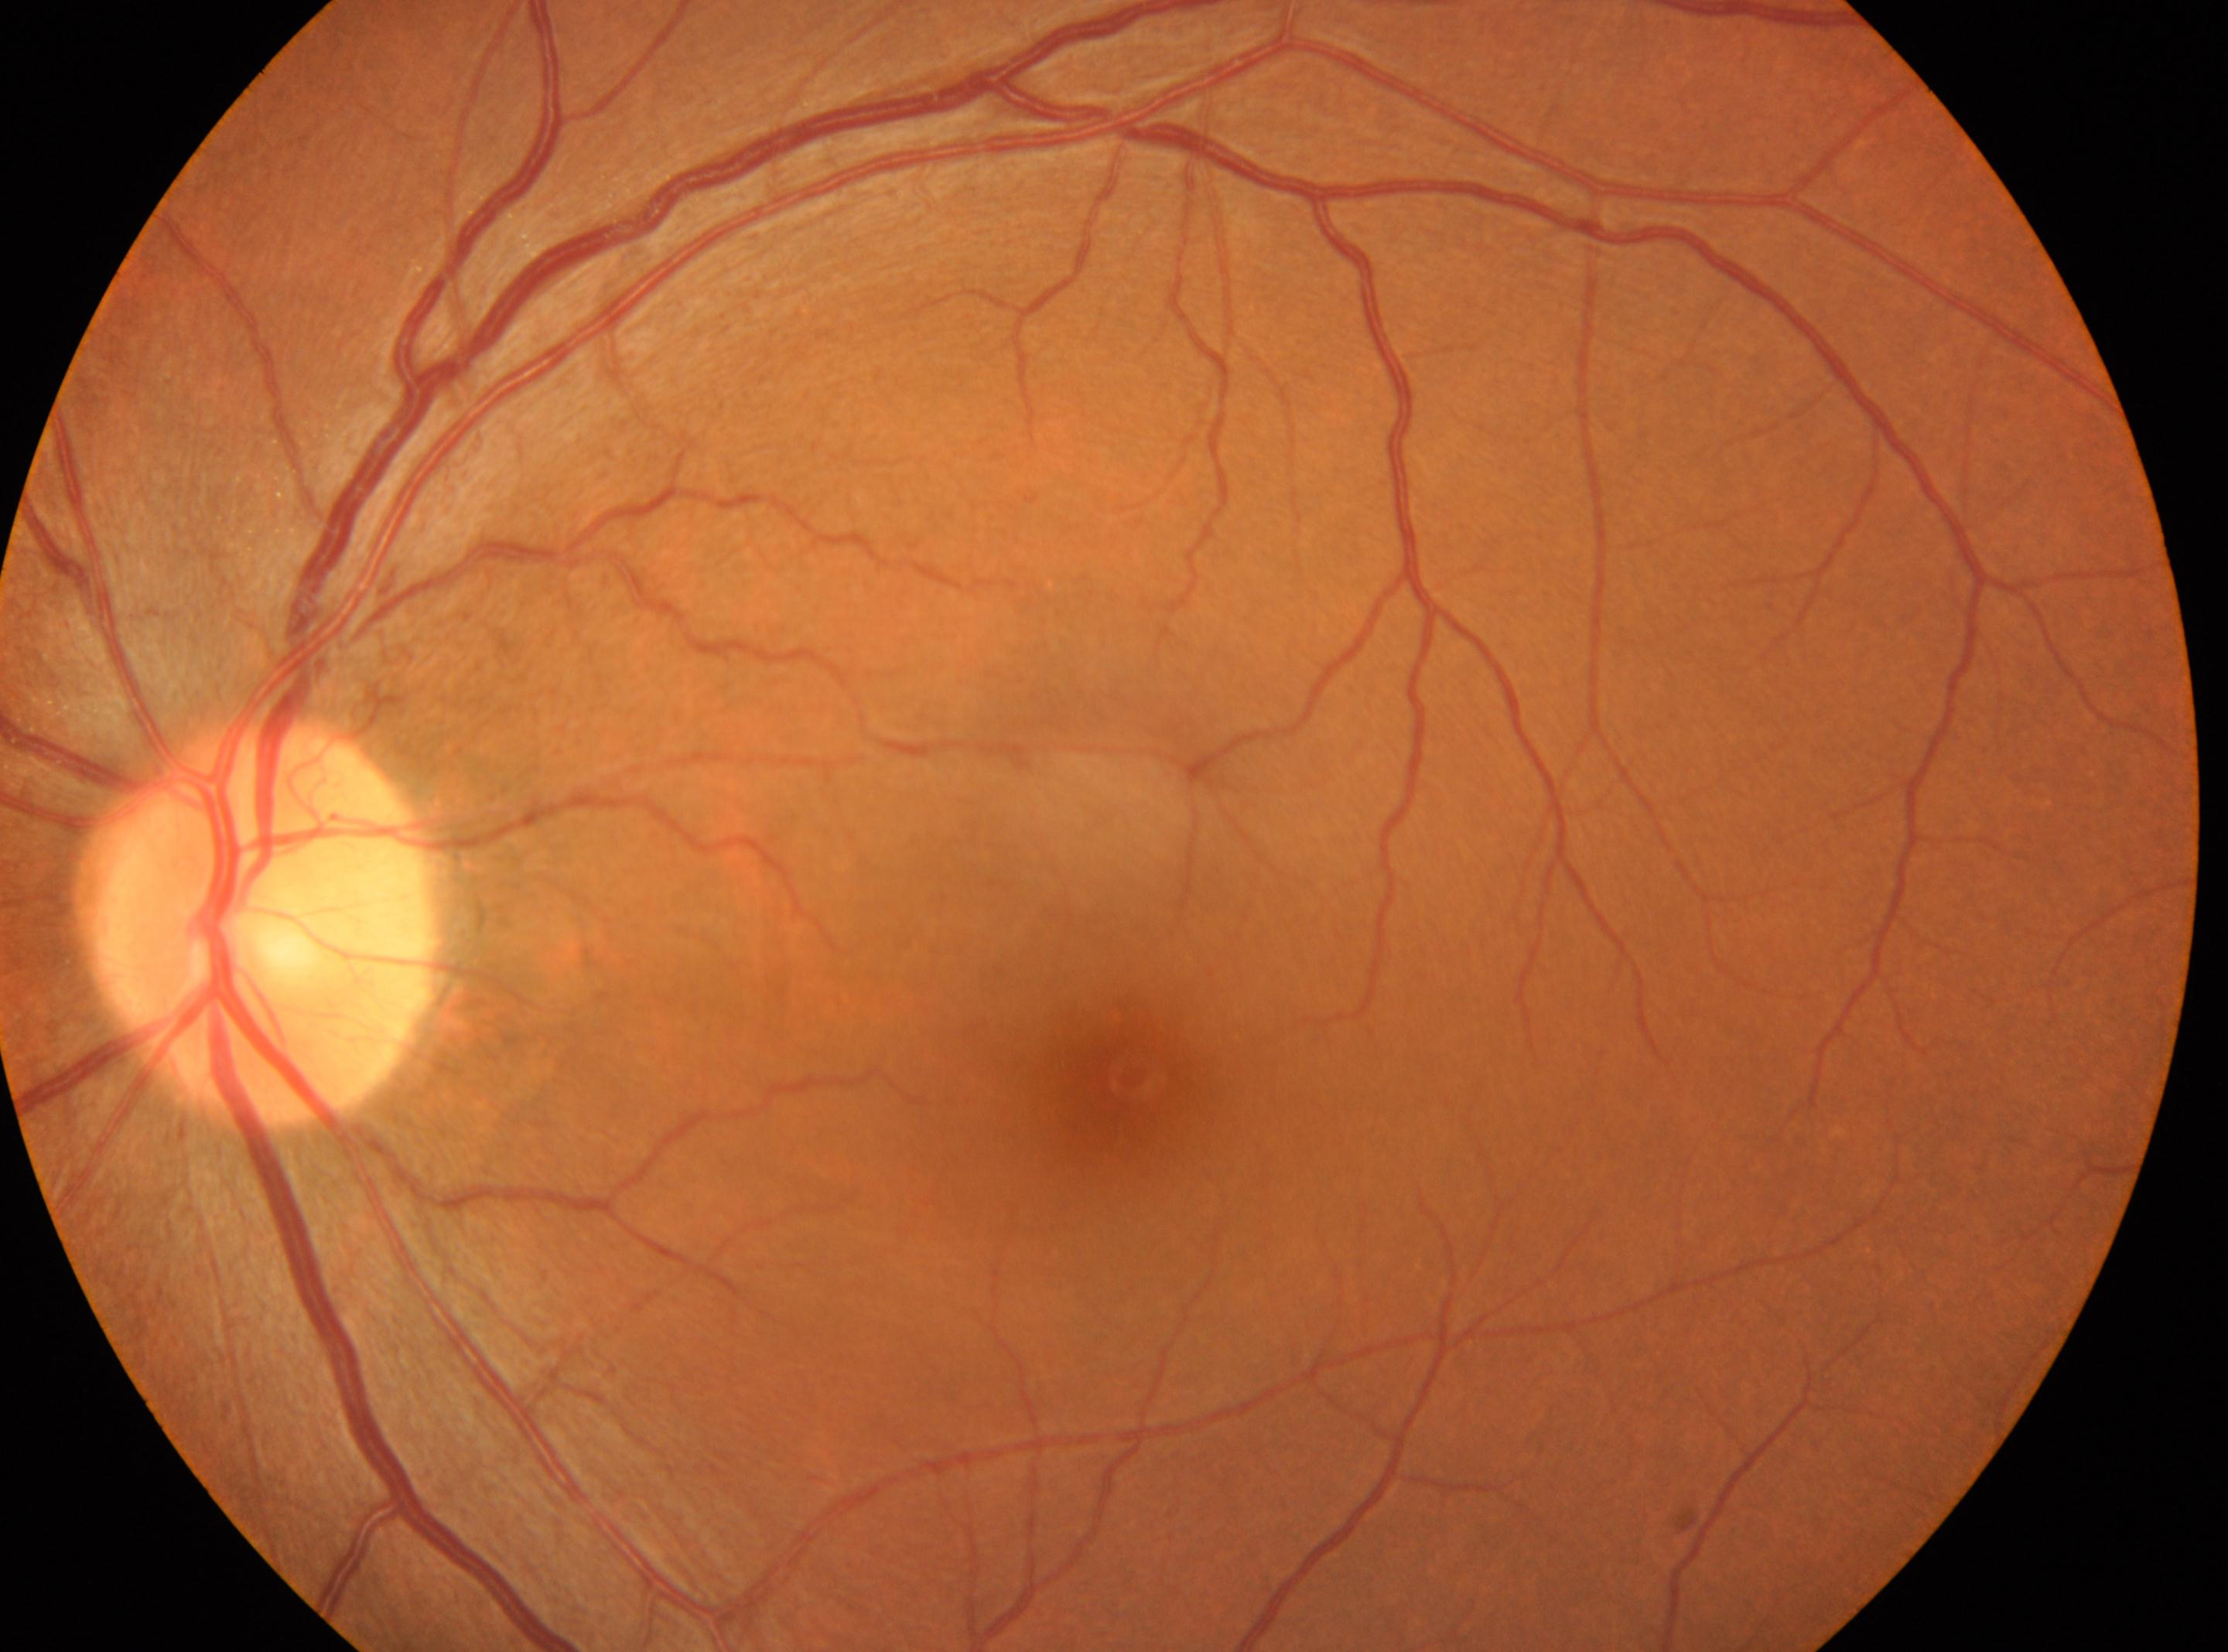

Macular center located at [1117, 1081].
Retinopathy: 0.
No diabetic retinopathy identified.
This is the left eye.
Optic disc: [255, 922].